2352 by 1568 pixels.
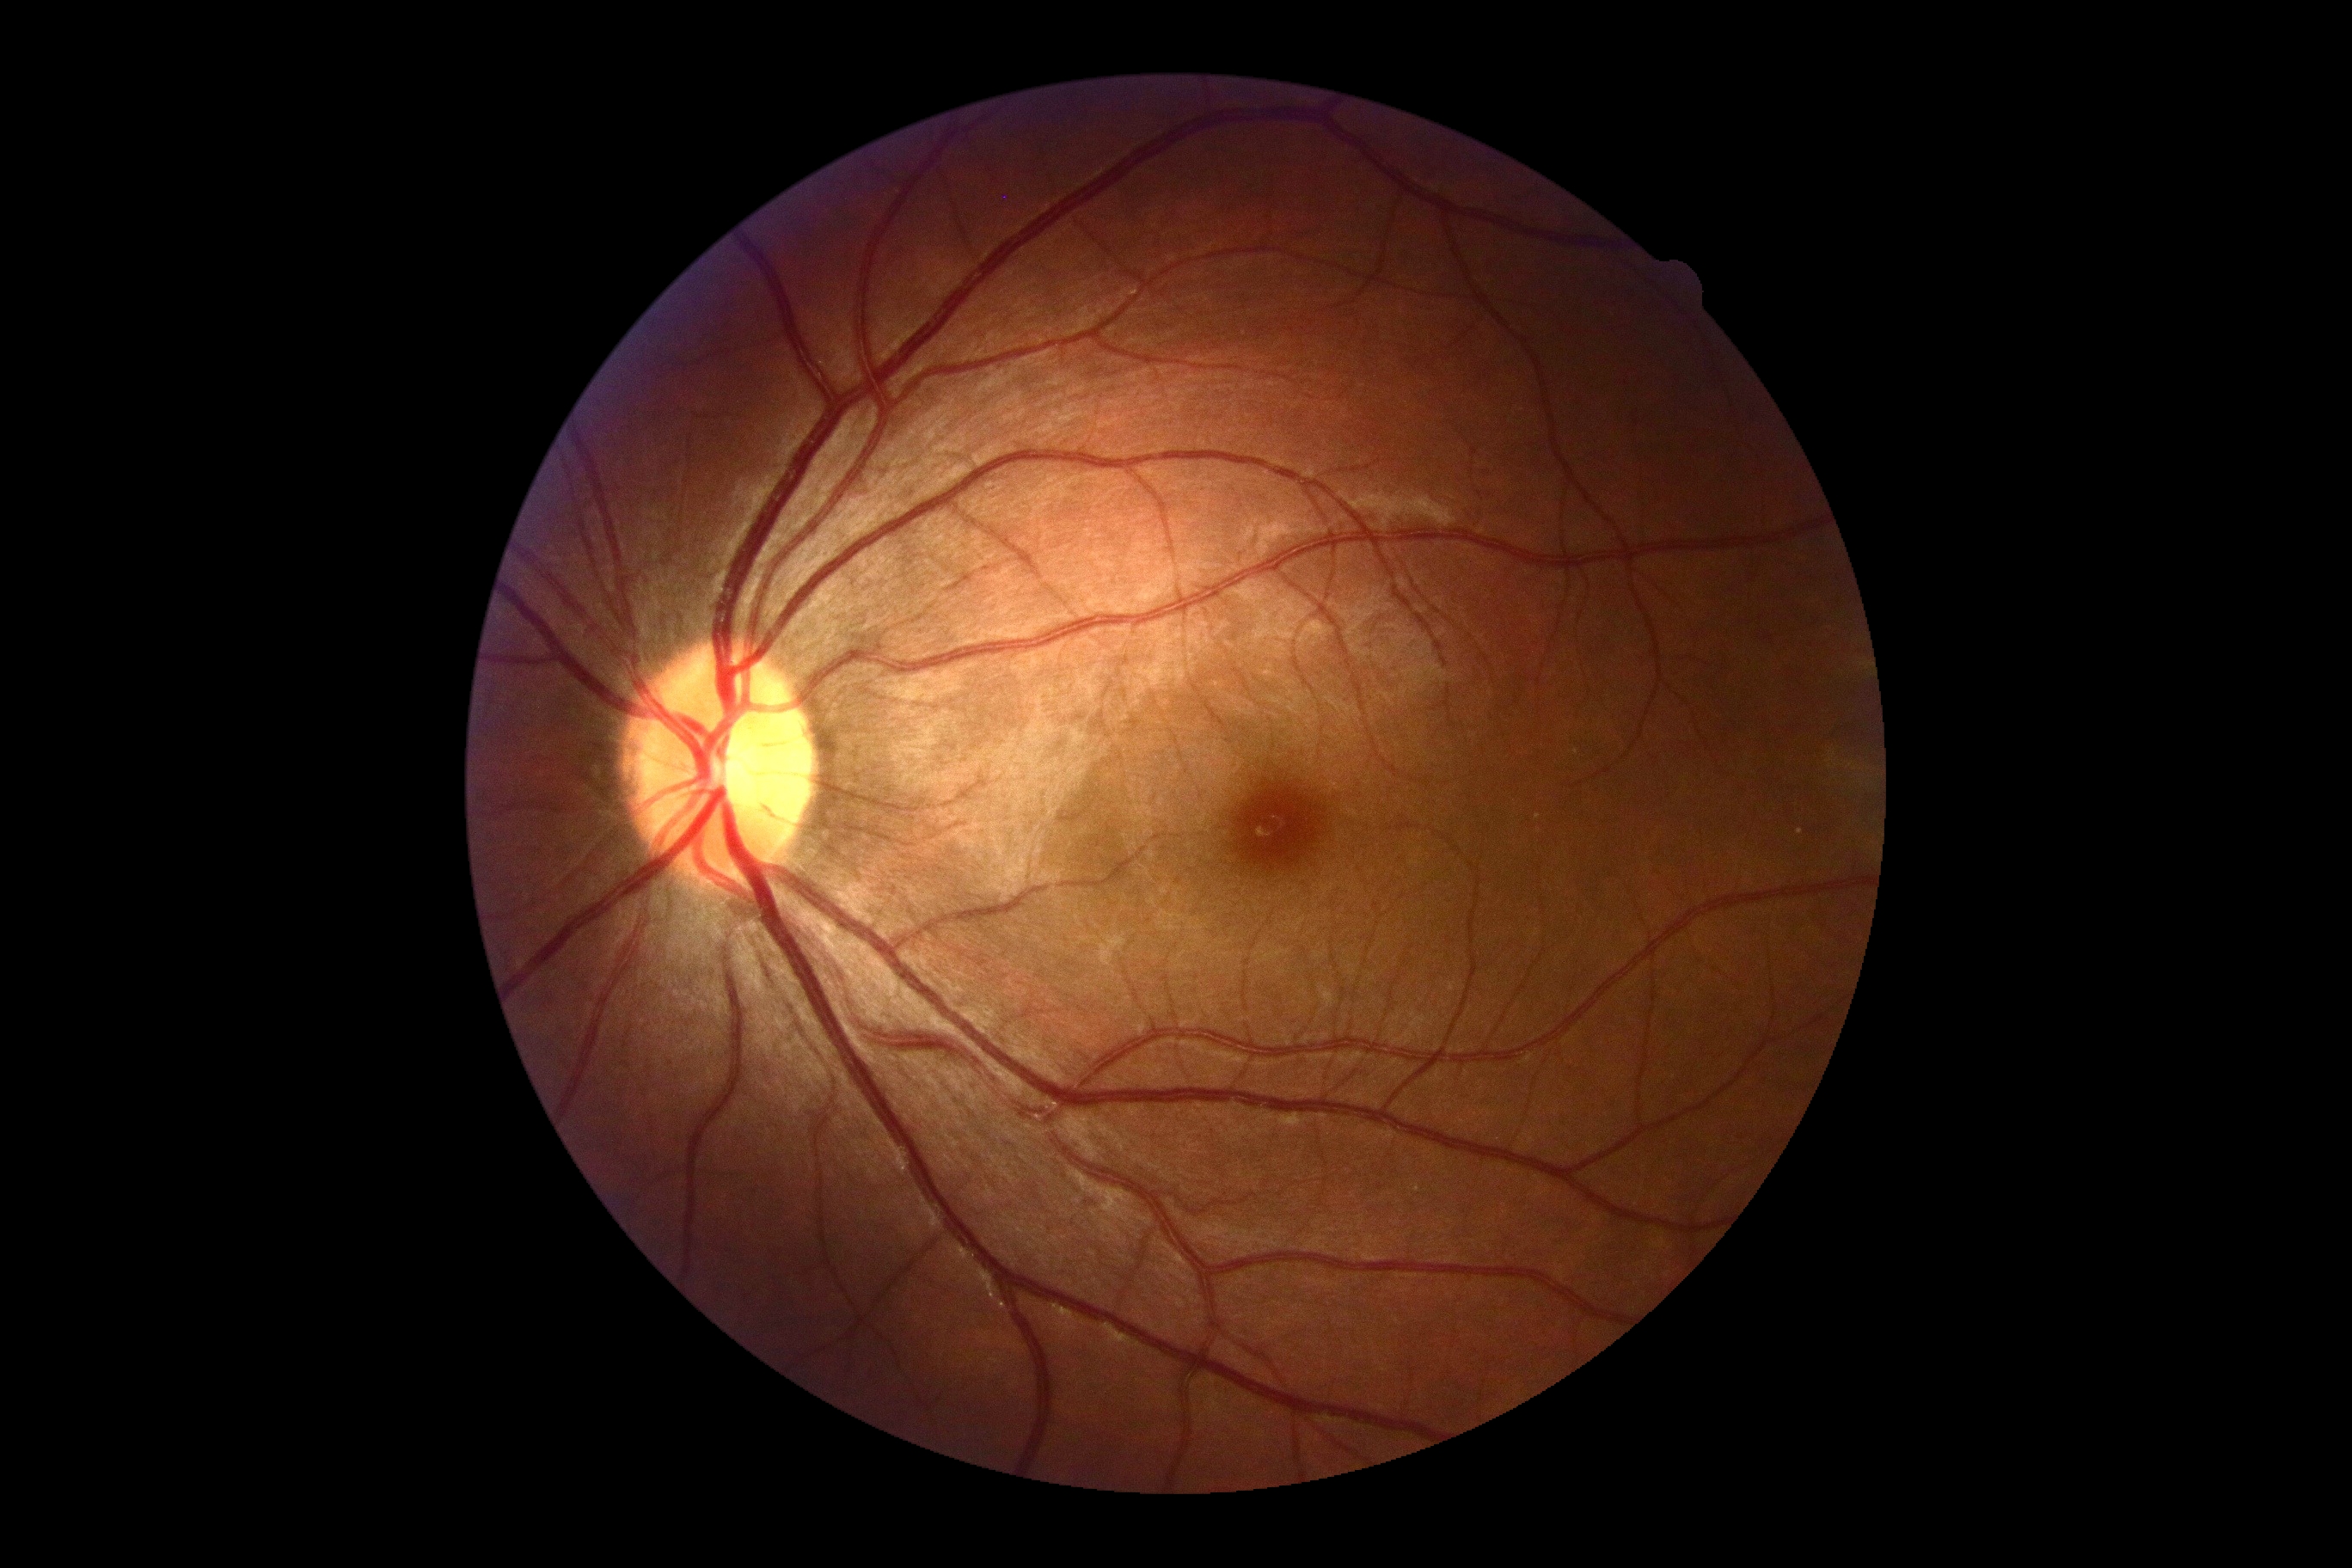

DR impression@no DR findings; retinopathy grade@0.